2352 by 1568 pixels.
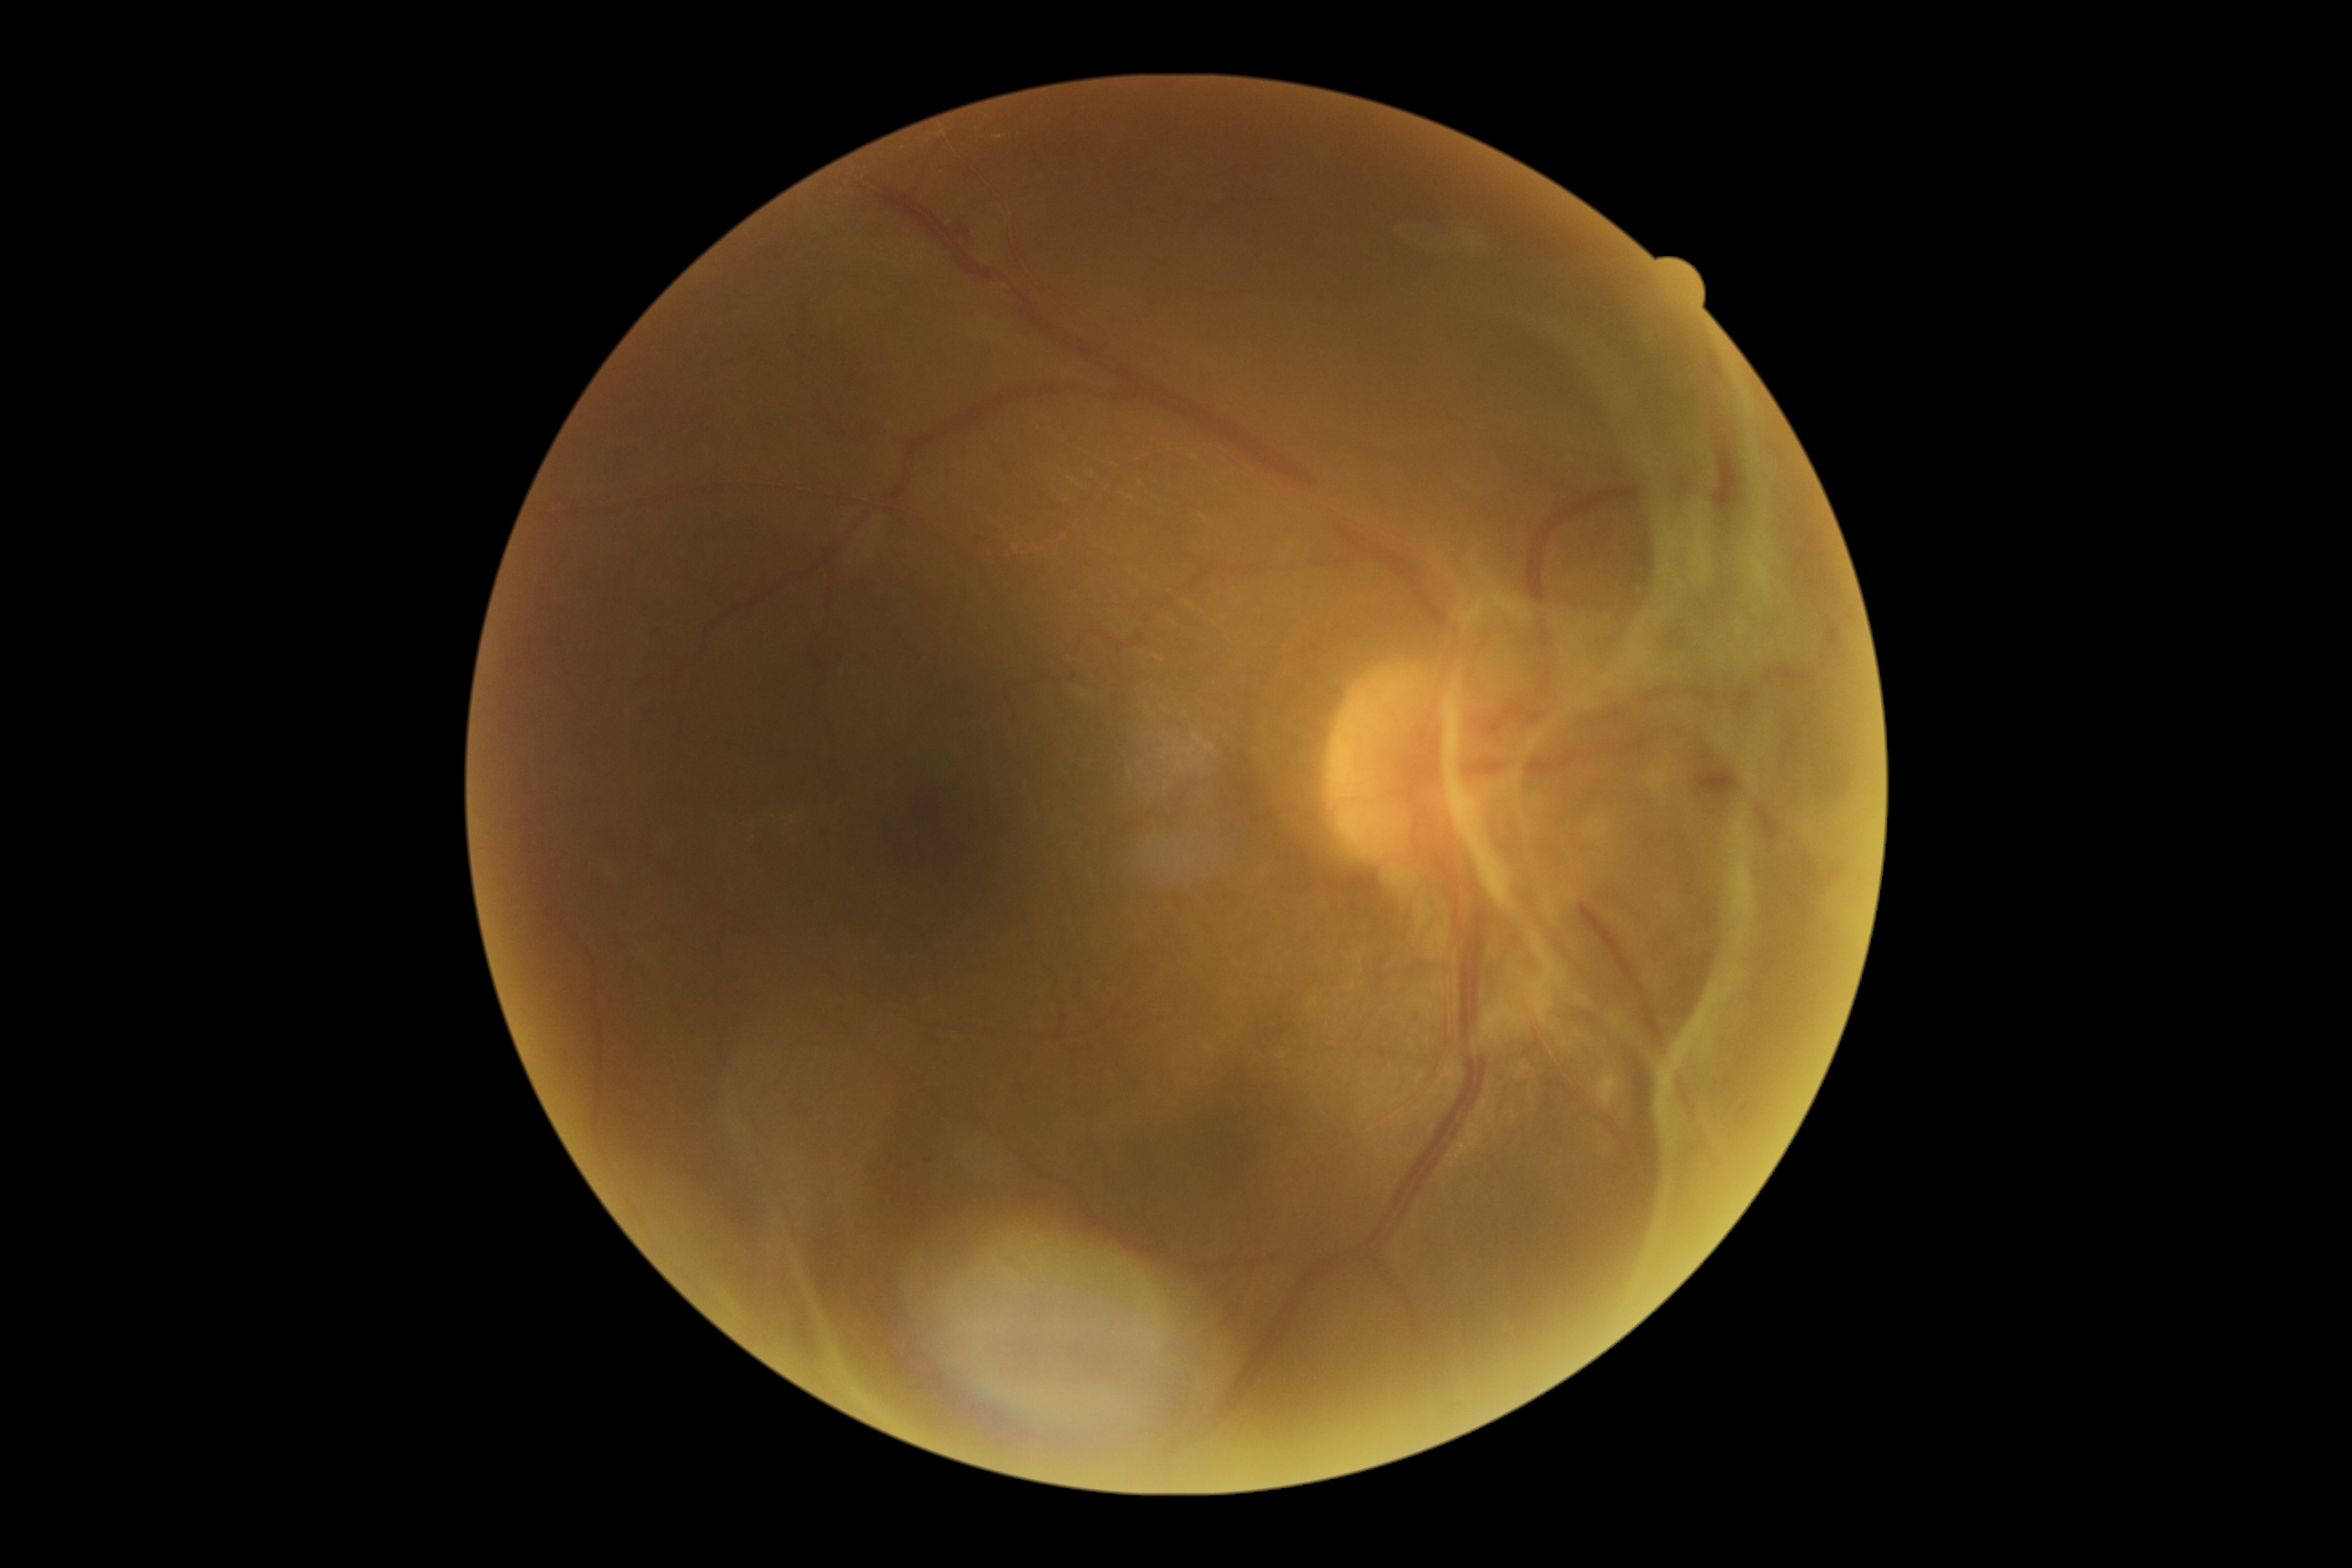

DR grade=4 — neovascularization and/or vitreous/pre-retinal hemorrhage.